1240x1240px. Wide-field fundus image from infant ROP screening. Captured with the Phoenix ICON (100° field of view)
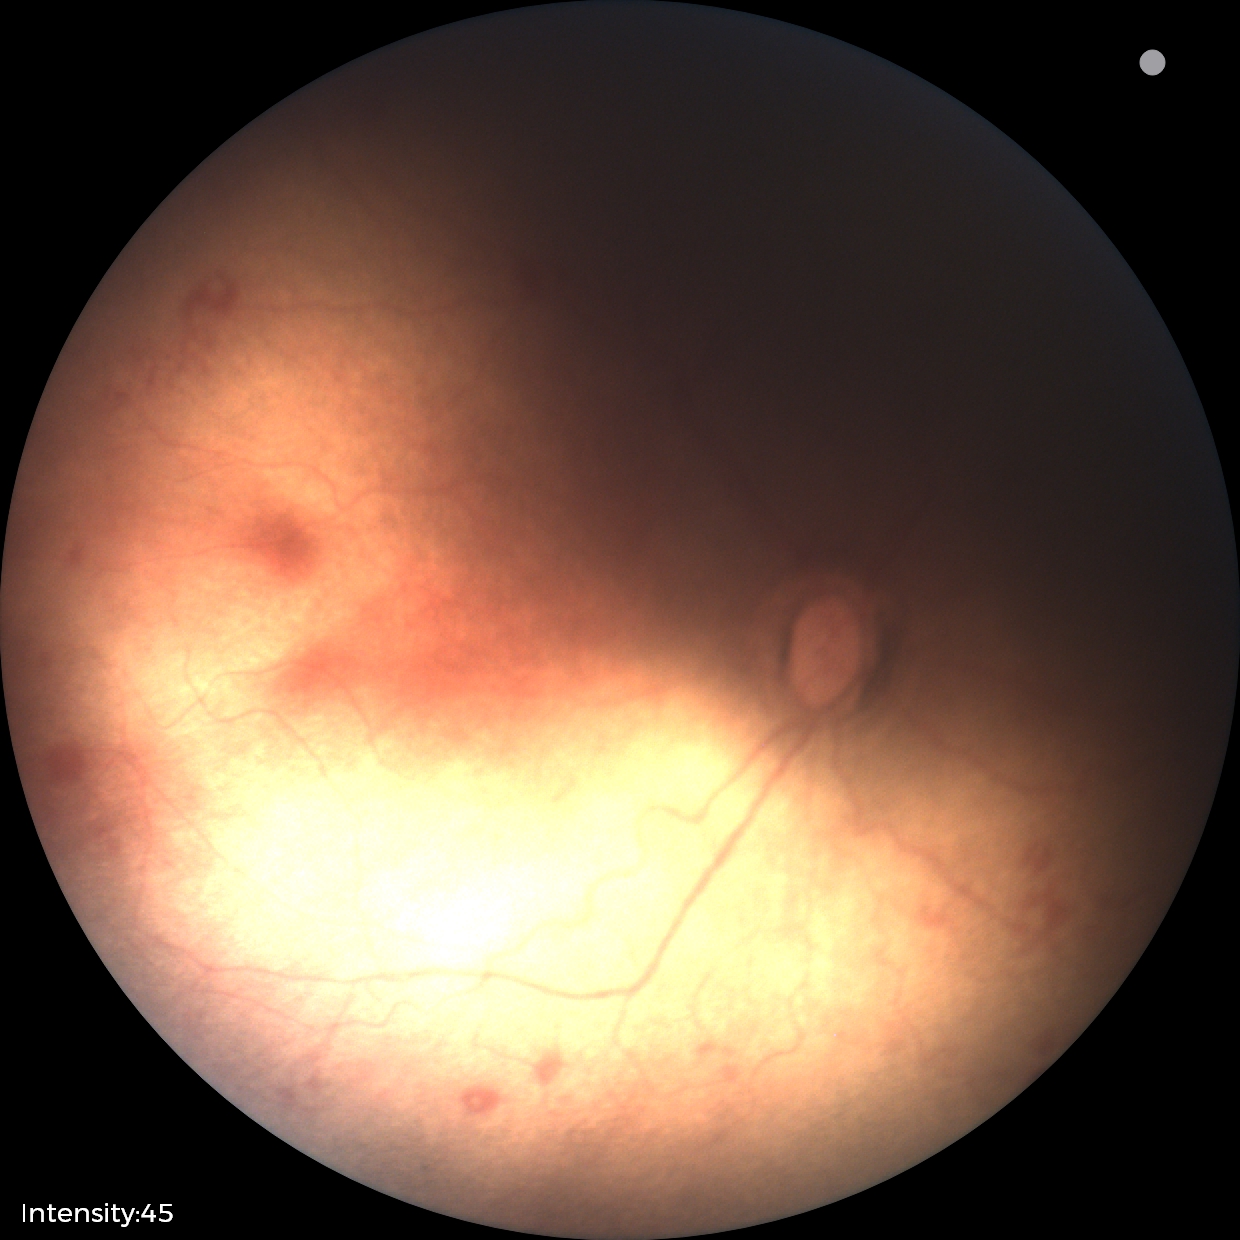
Series diagnosed as retinopathy of prematurity stage 1.